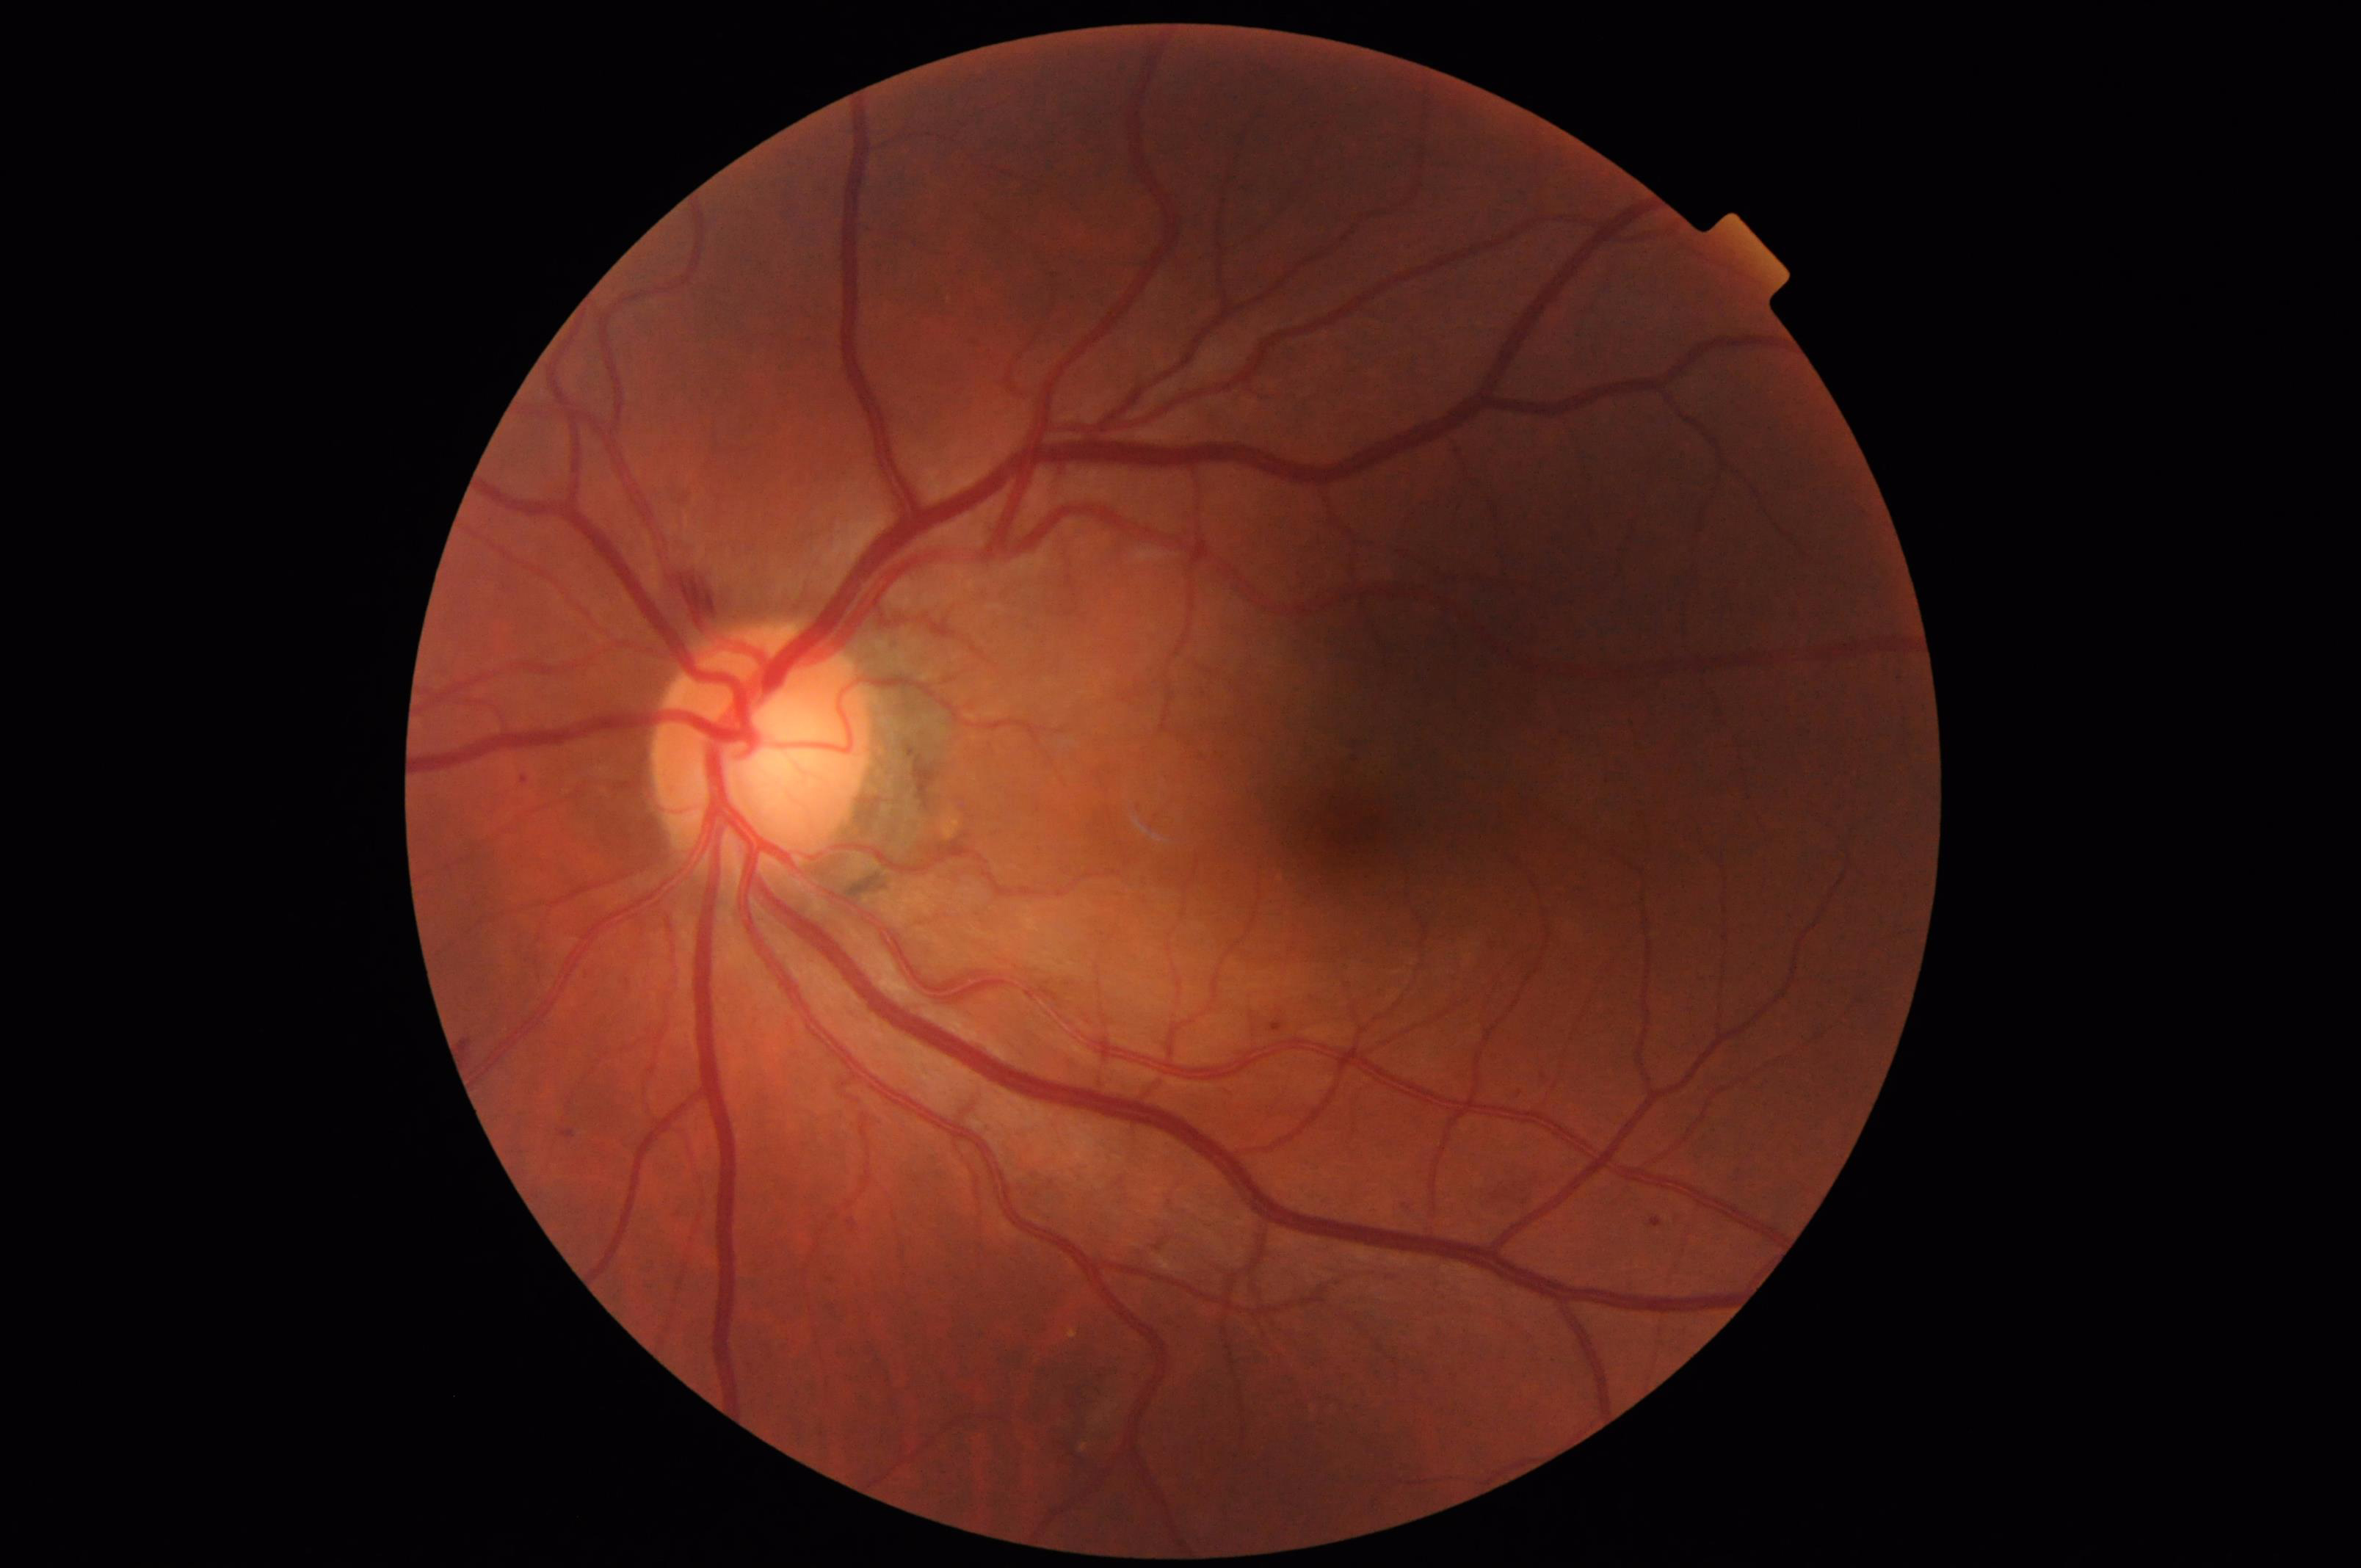

Quality grading:
- sharpness: optic disc, vessels, and background in focus
- overall: adequate for clinical interpretation